2048x1536px — 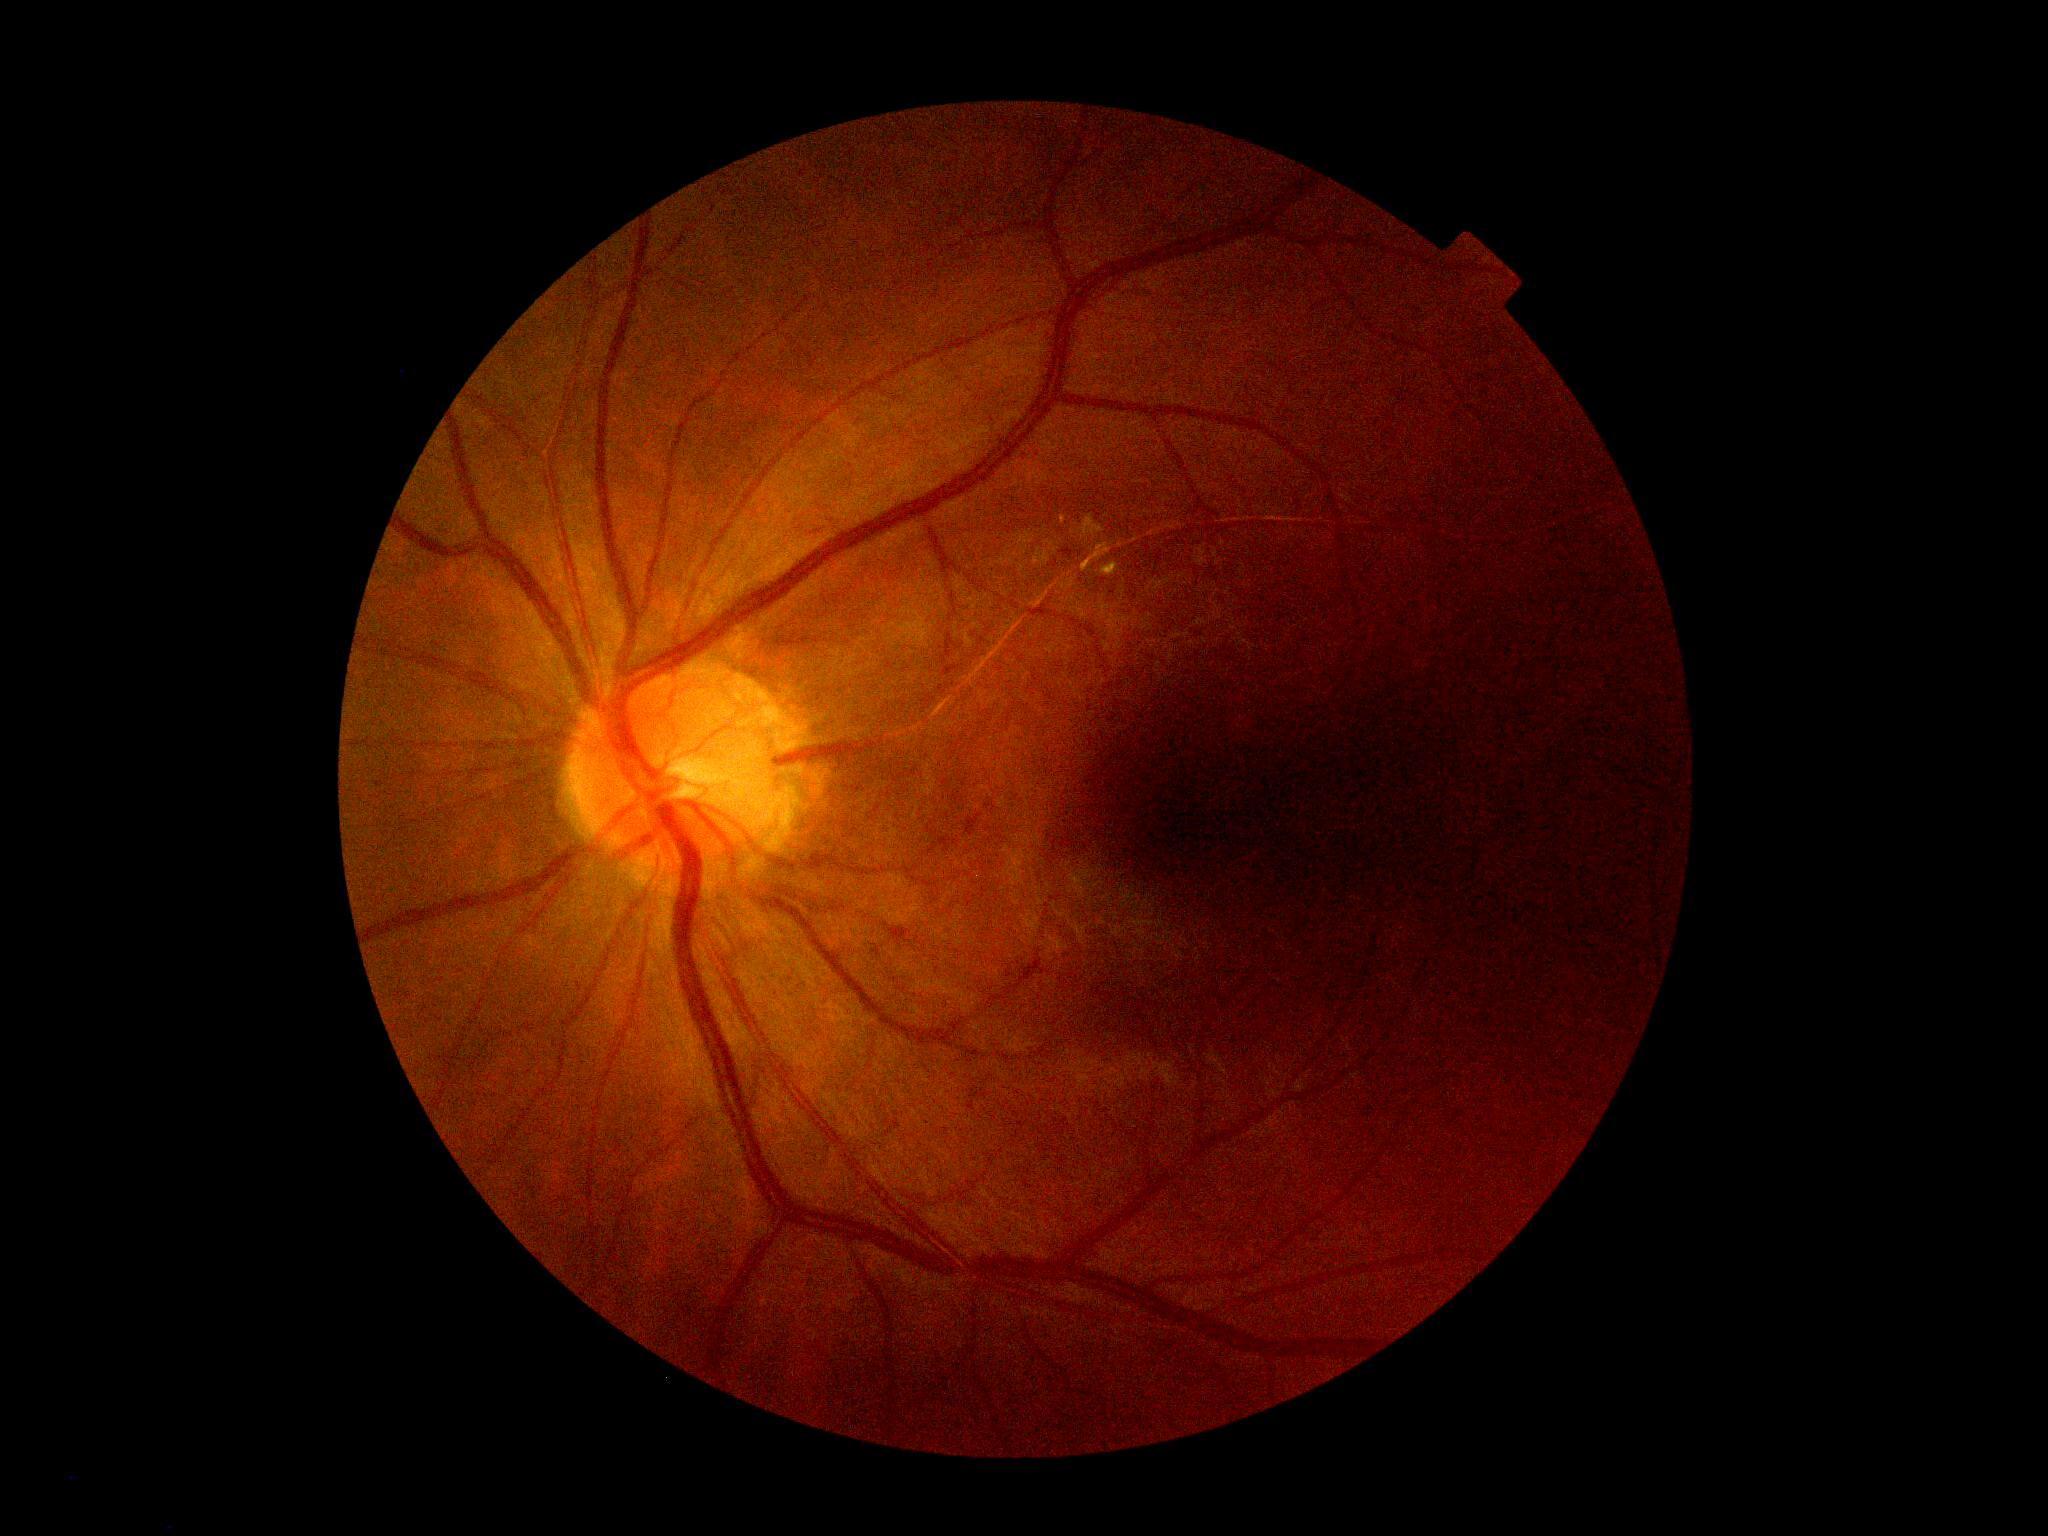
diabetic retinopathy=2/4 — more than just microaneurysms but less than severe NPDR, DR class=non-proliferative diabetic retinopathy.